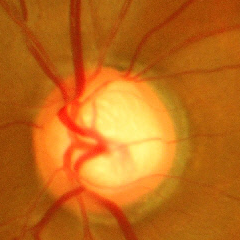
Optic disc photograph demonstrating severe glaucomatous damage.